848 by 848 pixels. NIDEK AFC-230.
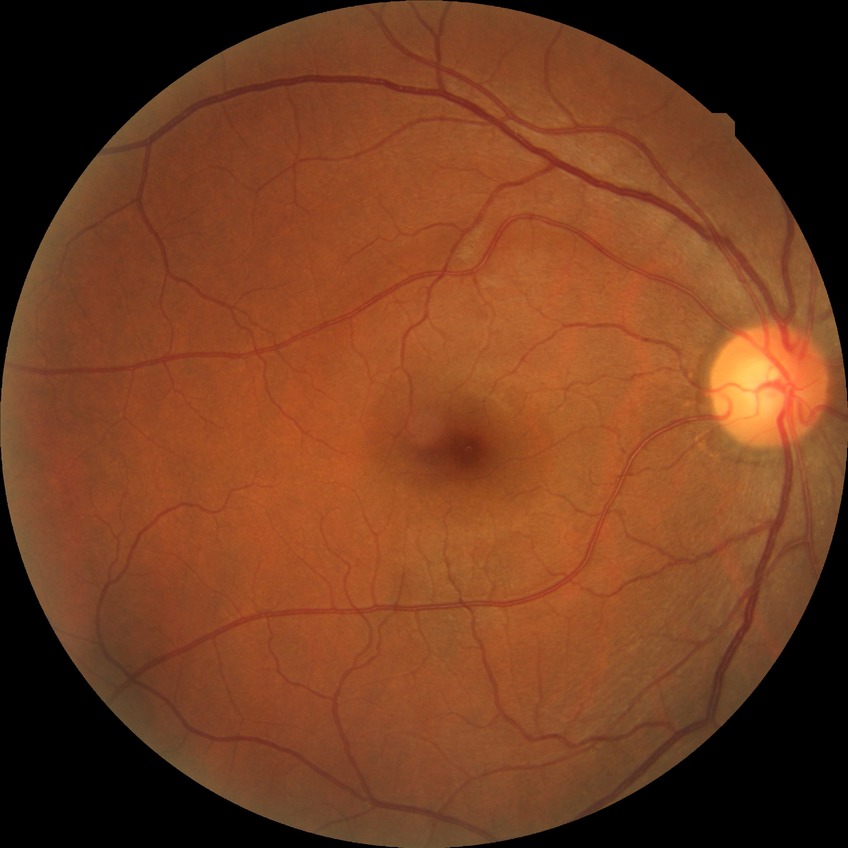

diabetic retinopathy stage = no diabetic retinopathy.